Camera: NIDEK AFC-230.
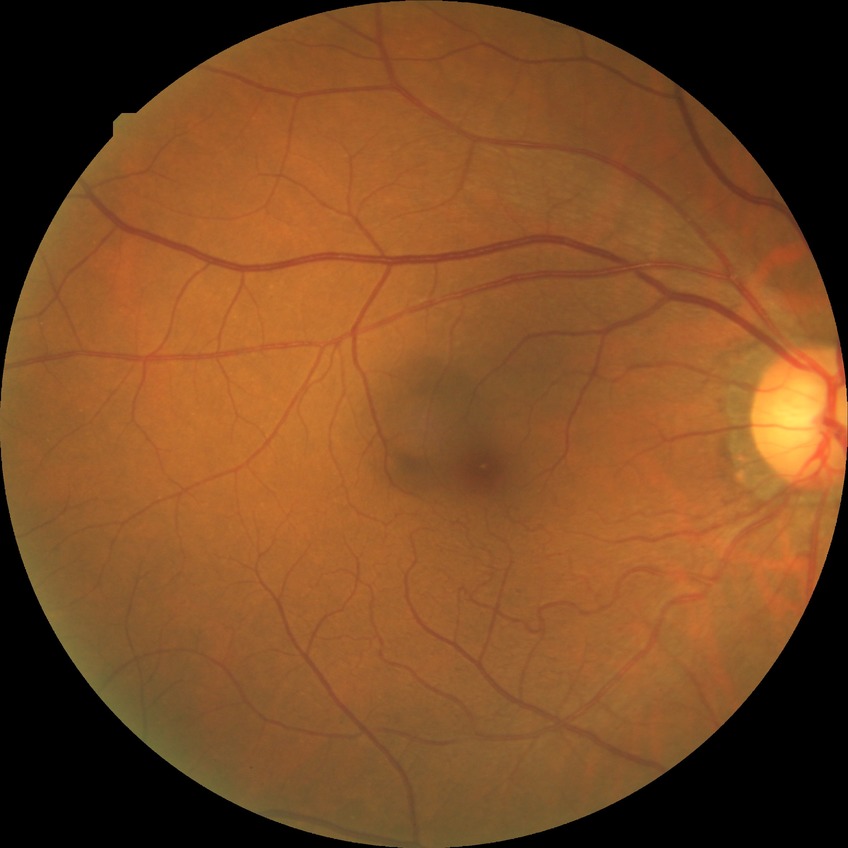

modified Davis grading = no diabetic retinopathy.